848 x 848 pixels · without pupil dilation · 45 degree fundus photograph — 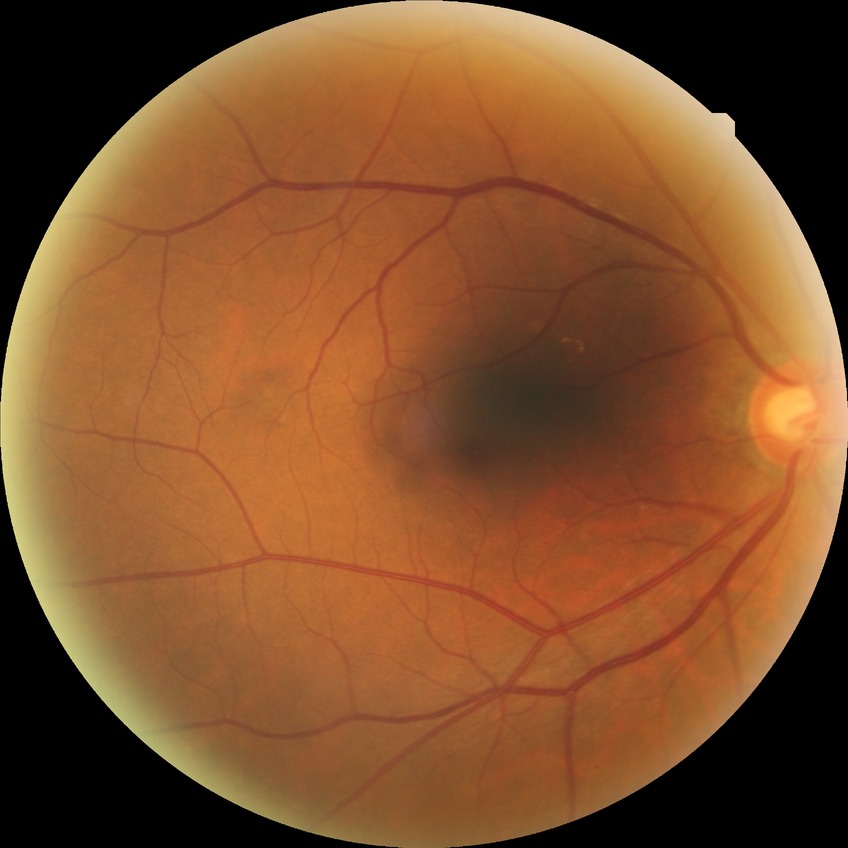 Modified Davis classification: no diabetic retinopathy.